1240 by 1240 pixels · pediatric wide-field fundus photograph — 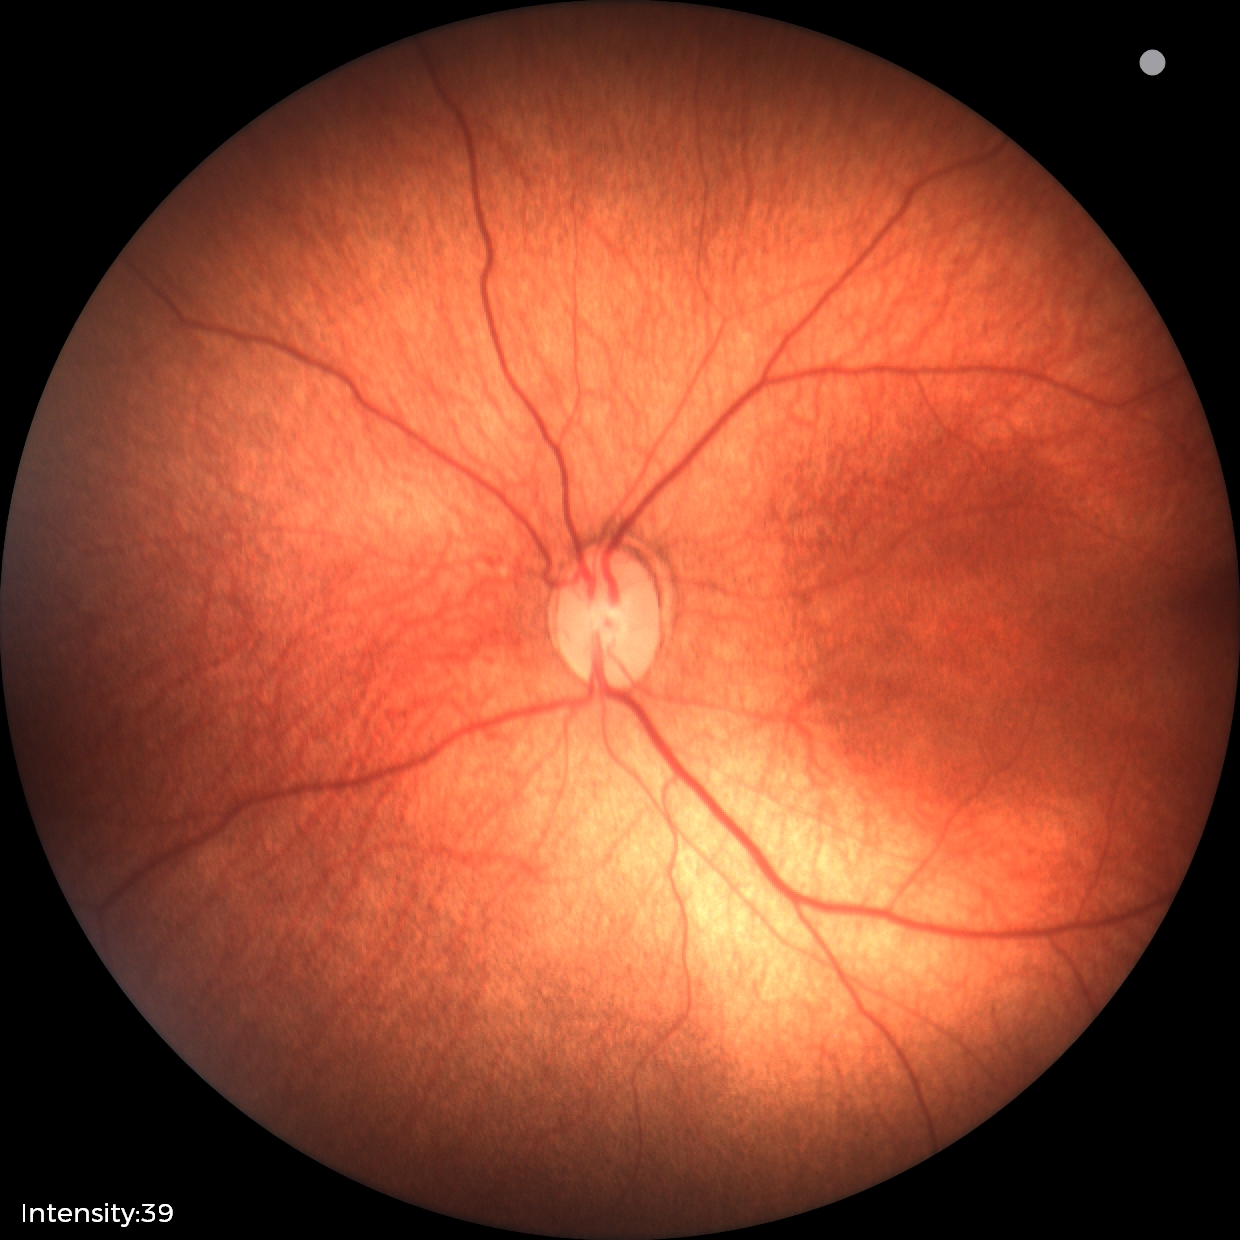 From an examination with diagnosis of status post retinopathy of prematurity.
Without plus disease.